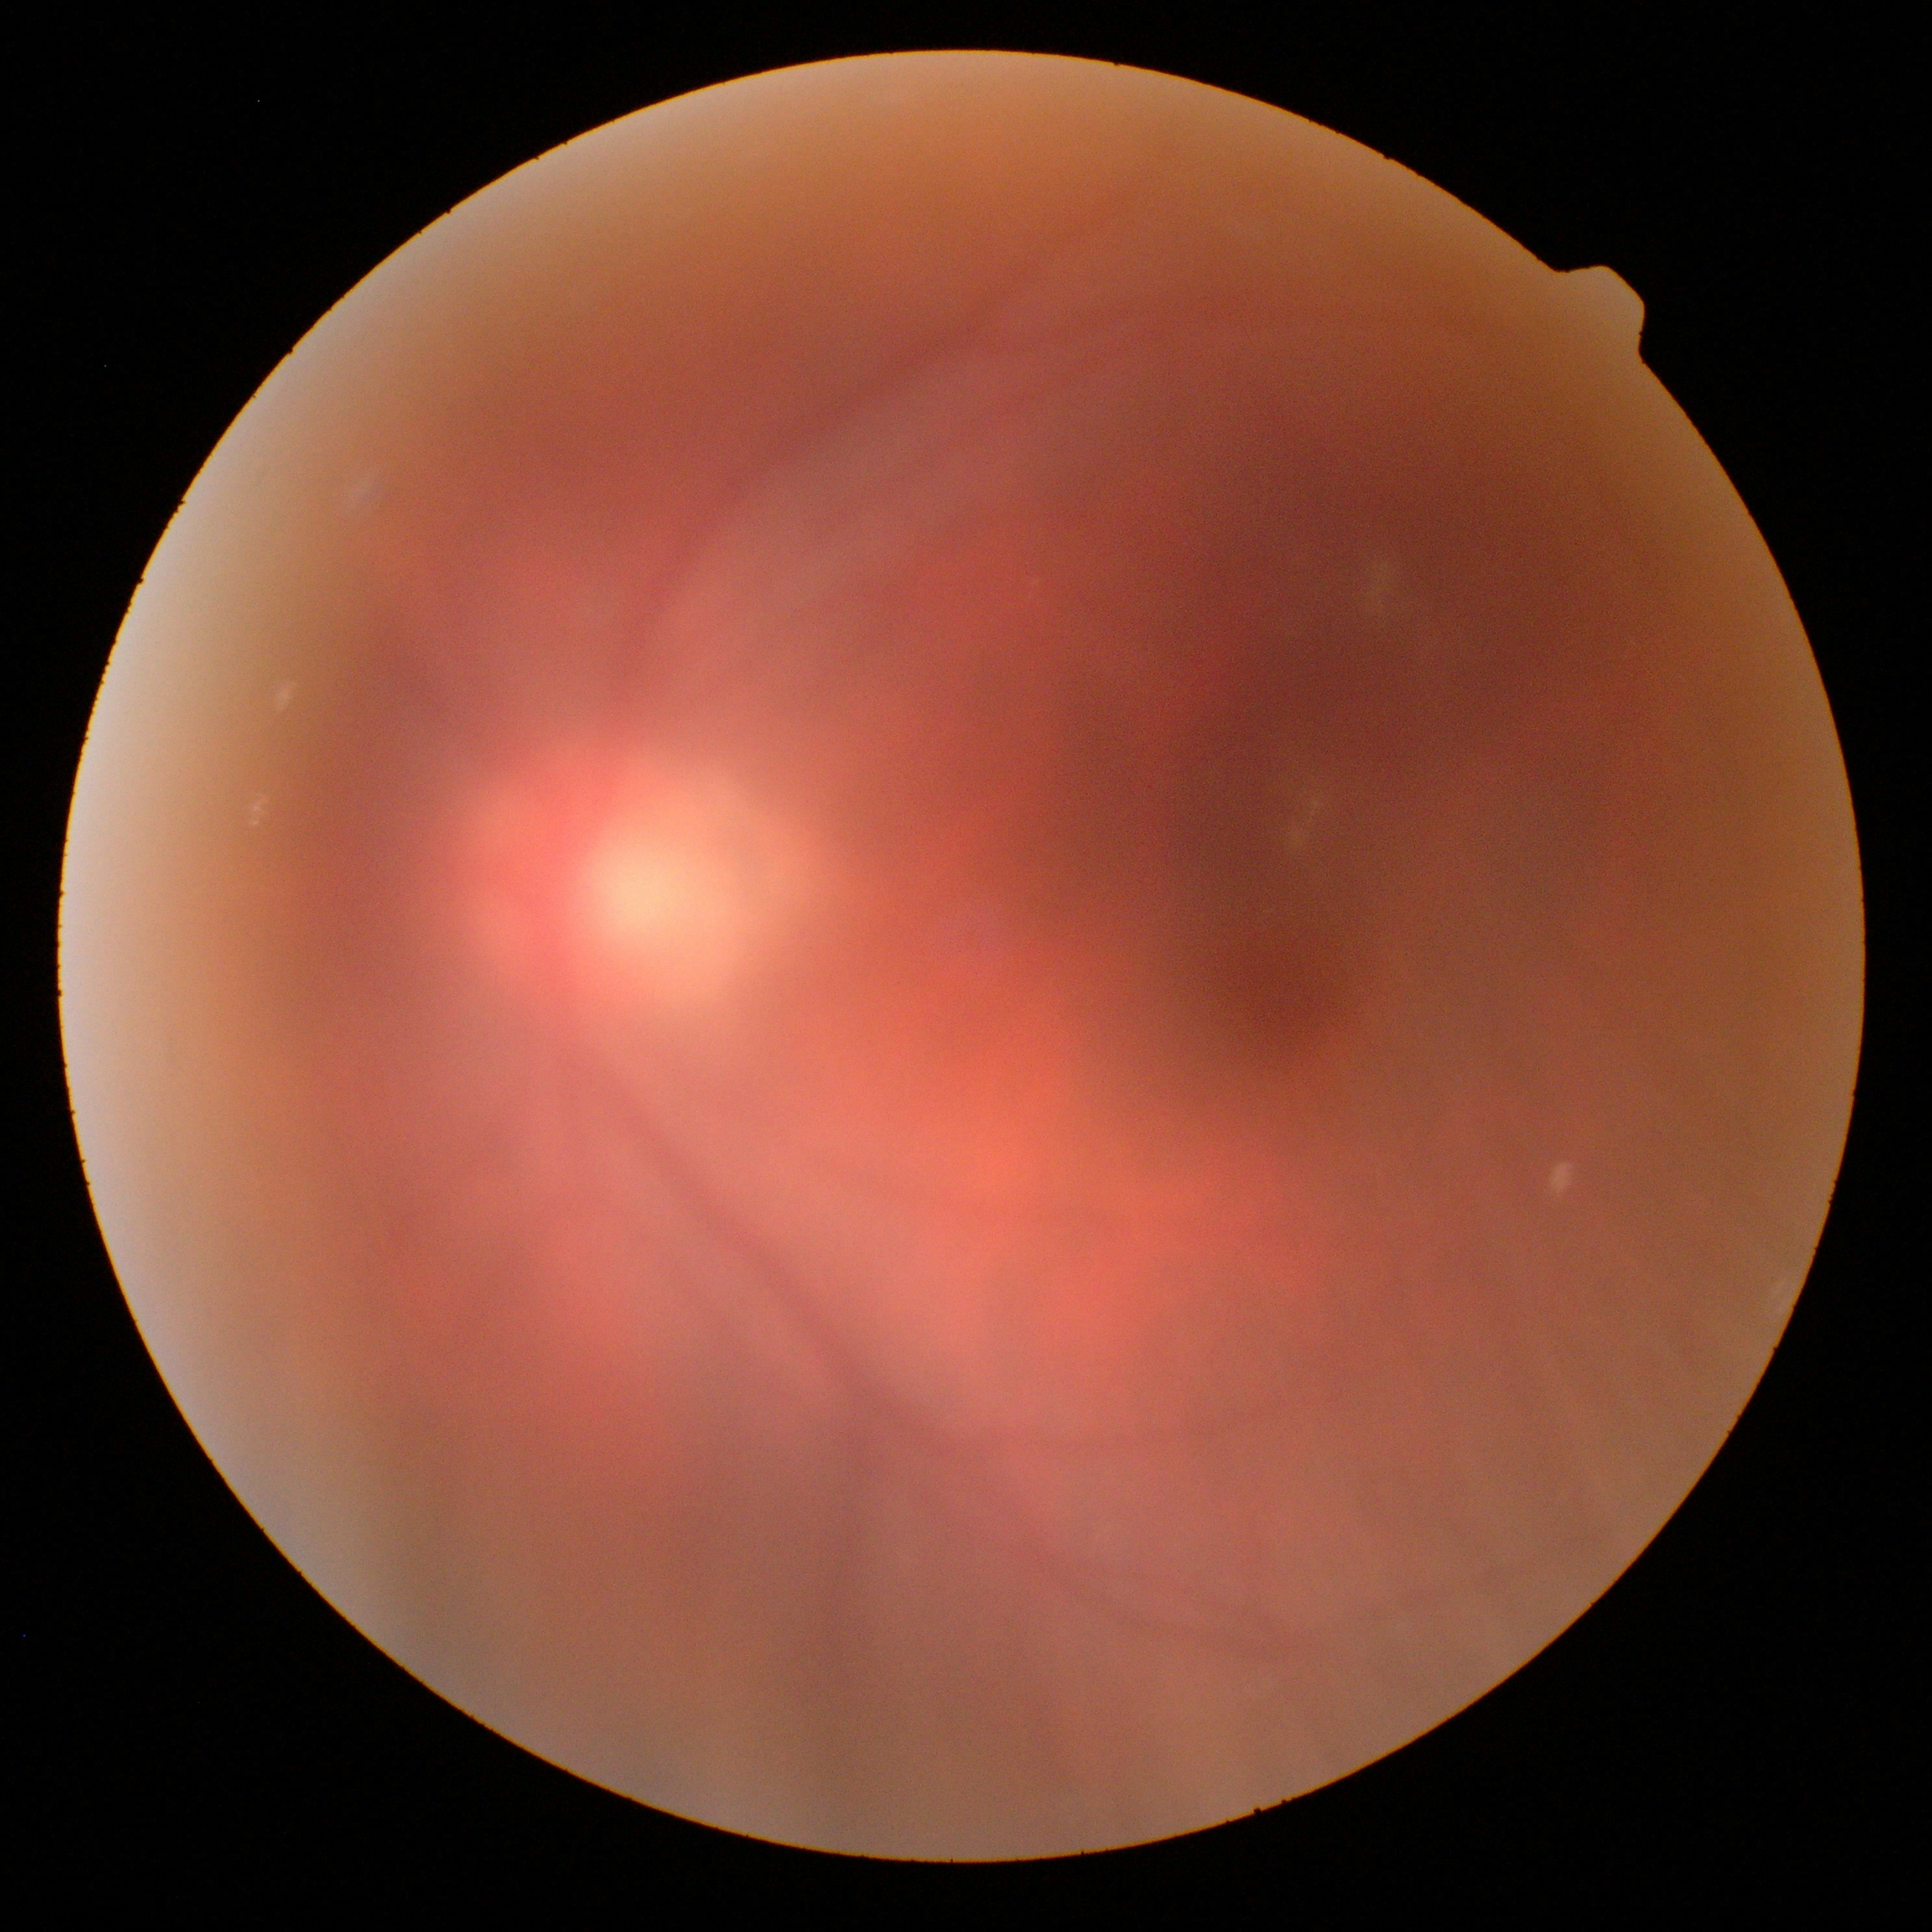 Diabetic retinopathy grade: 0 (no apparent retinopathy).